Pediatric wide-field fundus photograph — 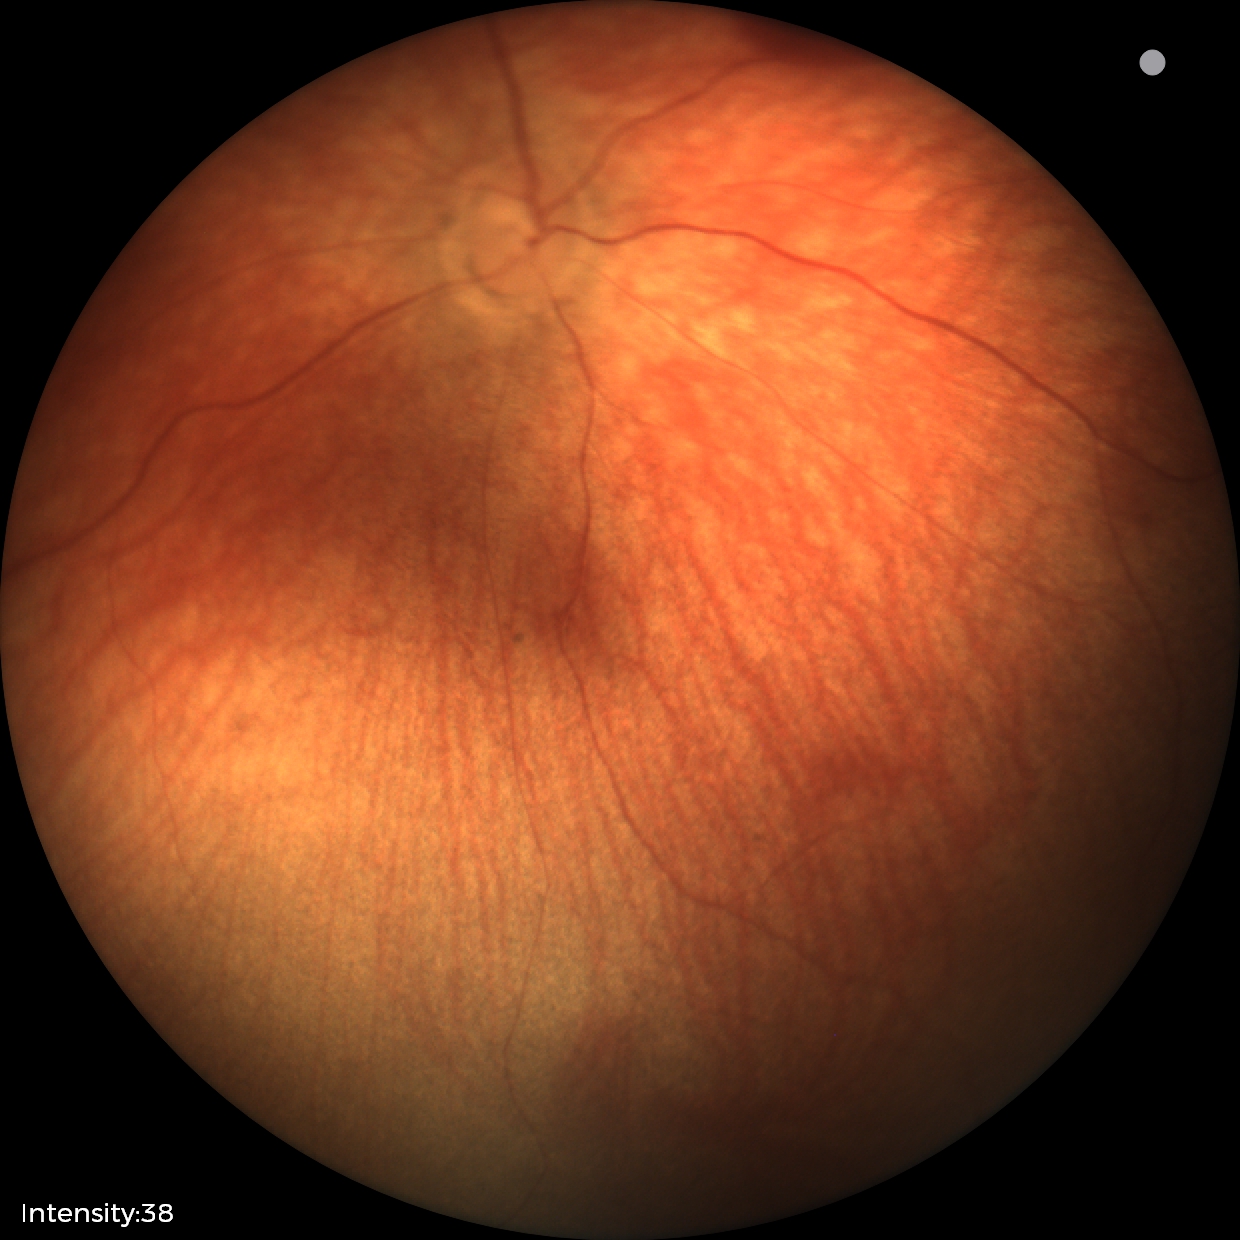
Screening series with retinal hemorrhages.